1932x1916. 45° FOV. Fundus photo.
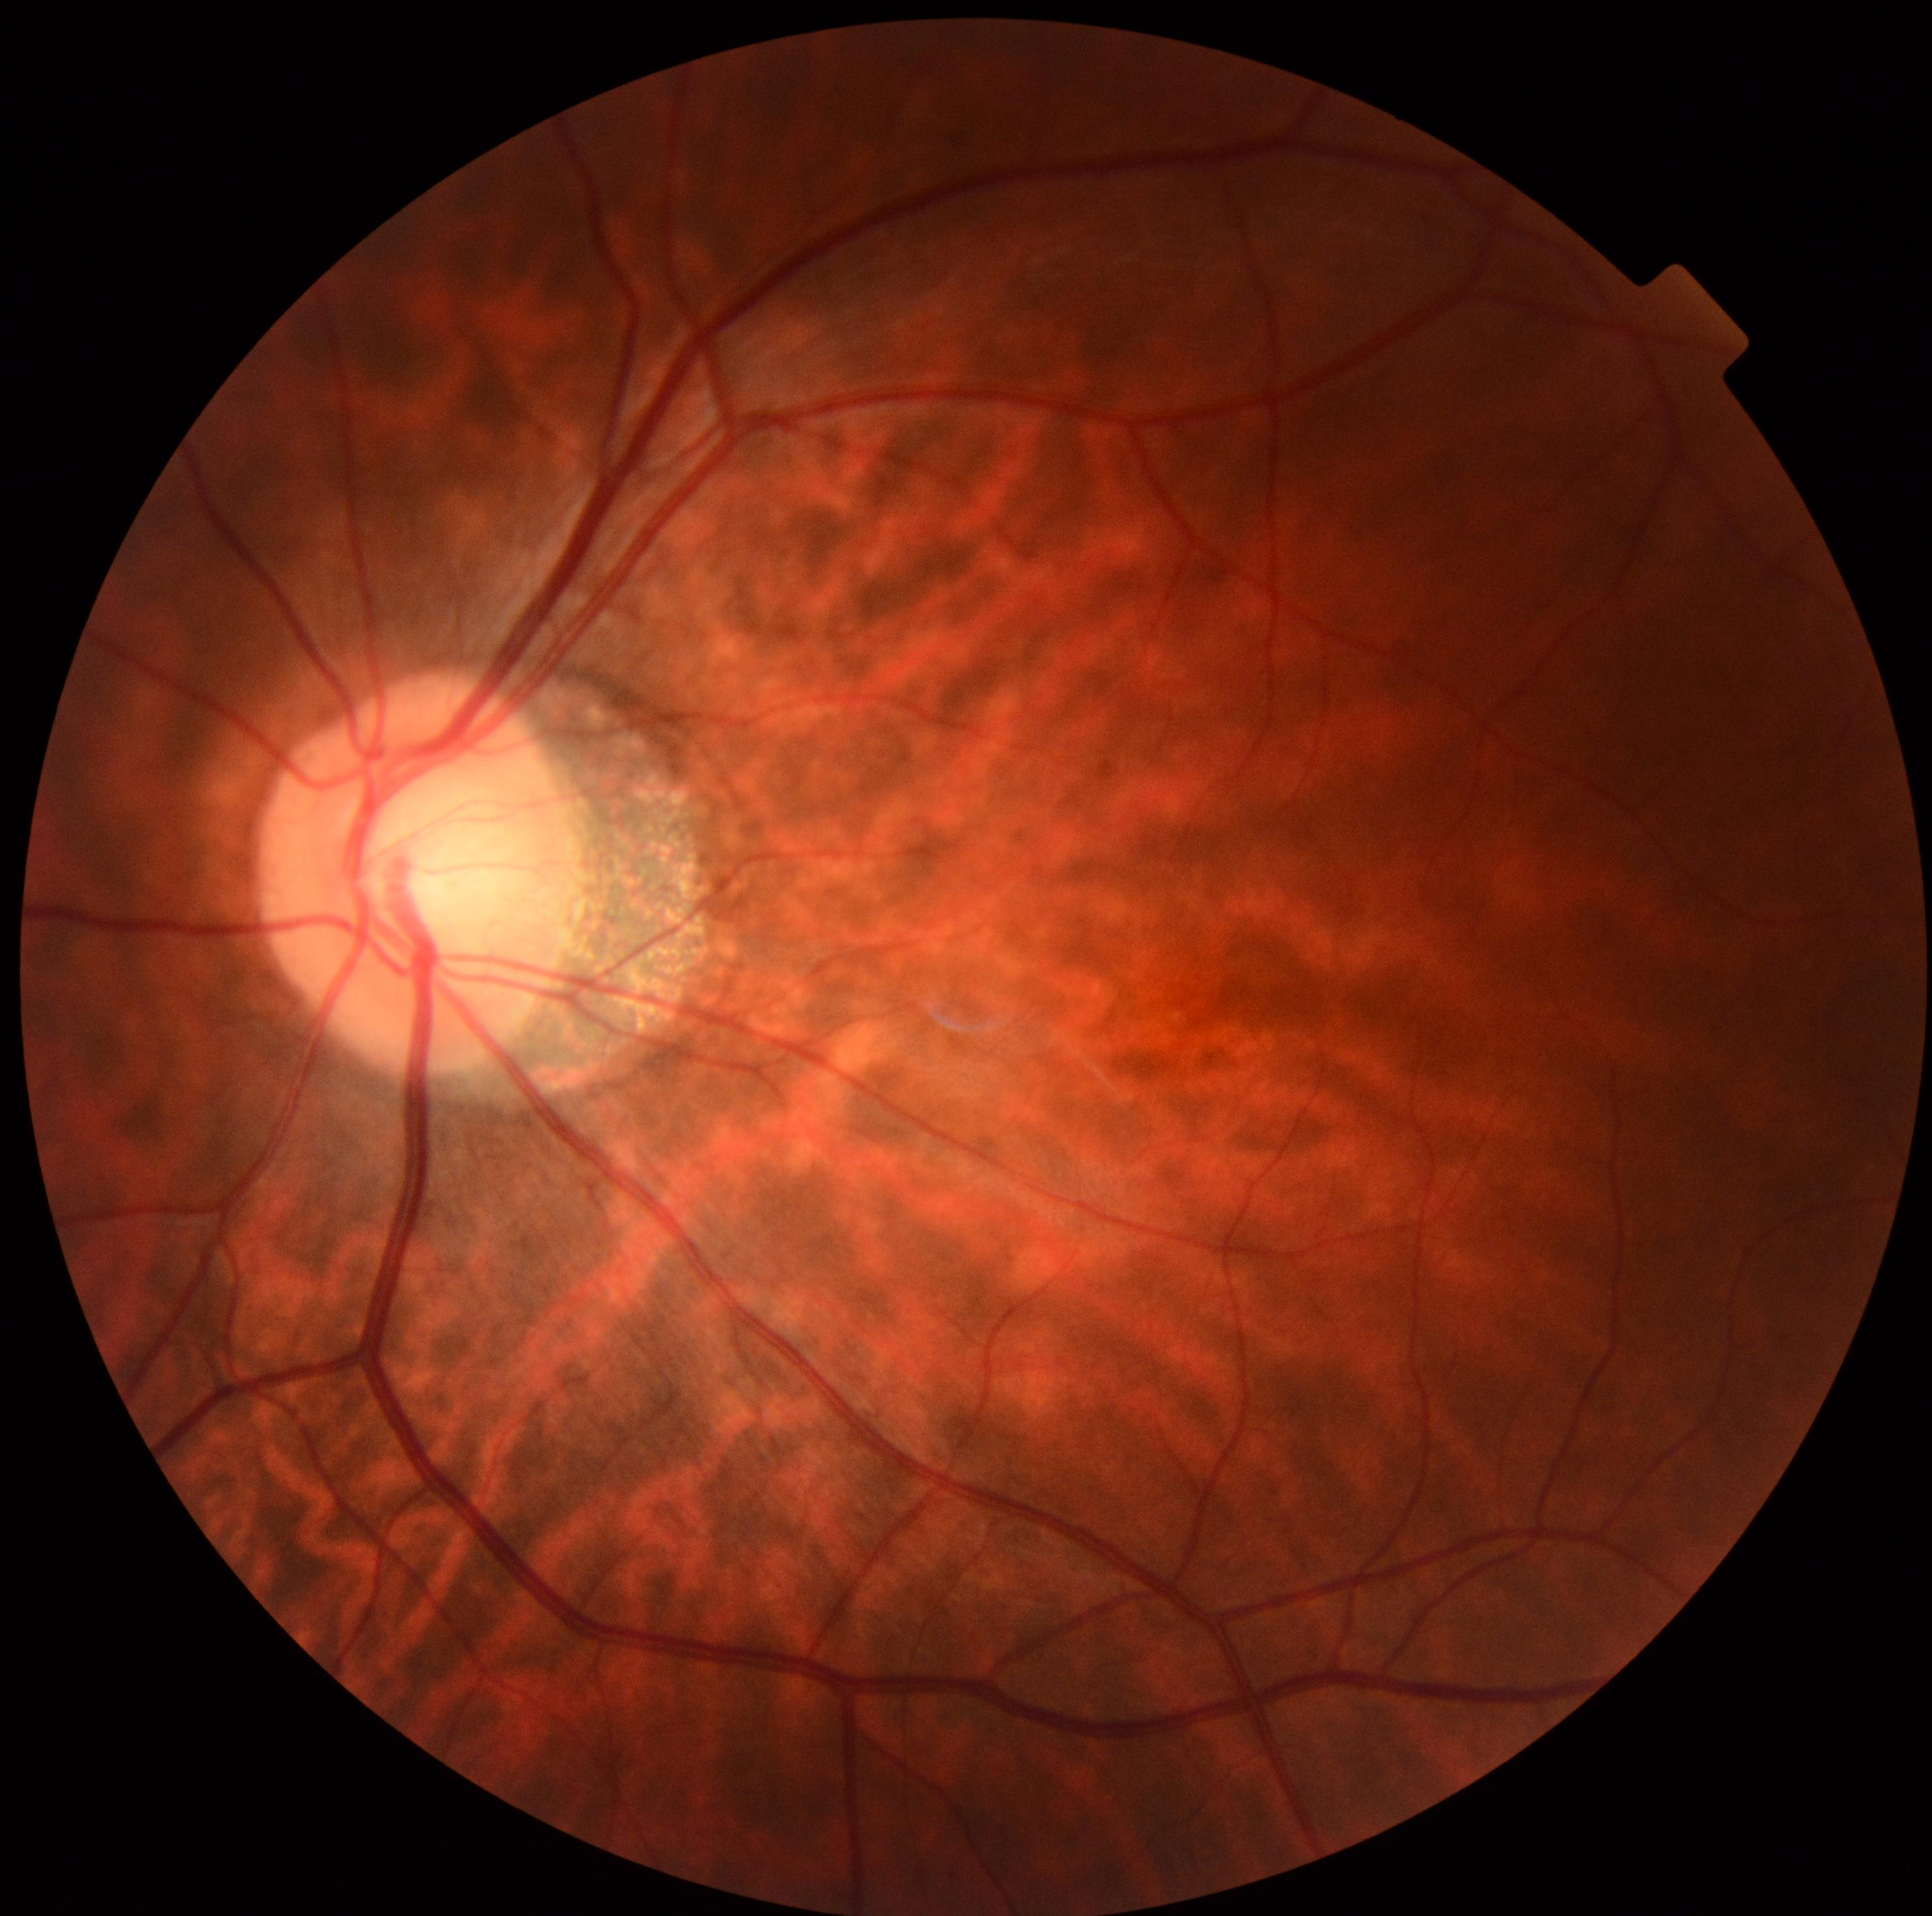

diabetic retinopathy (DR): 0 — no visible signs of diabetic retinopathy
DR impression: negative for DR